2048x1536px; 45° field of view: 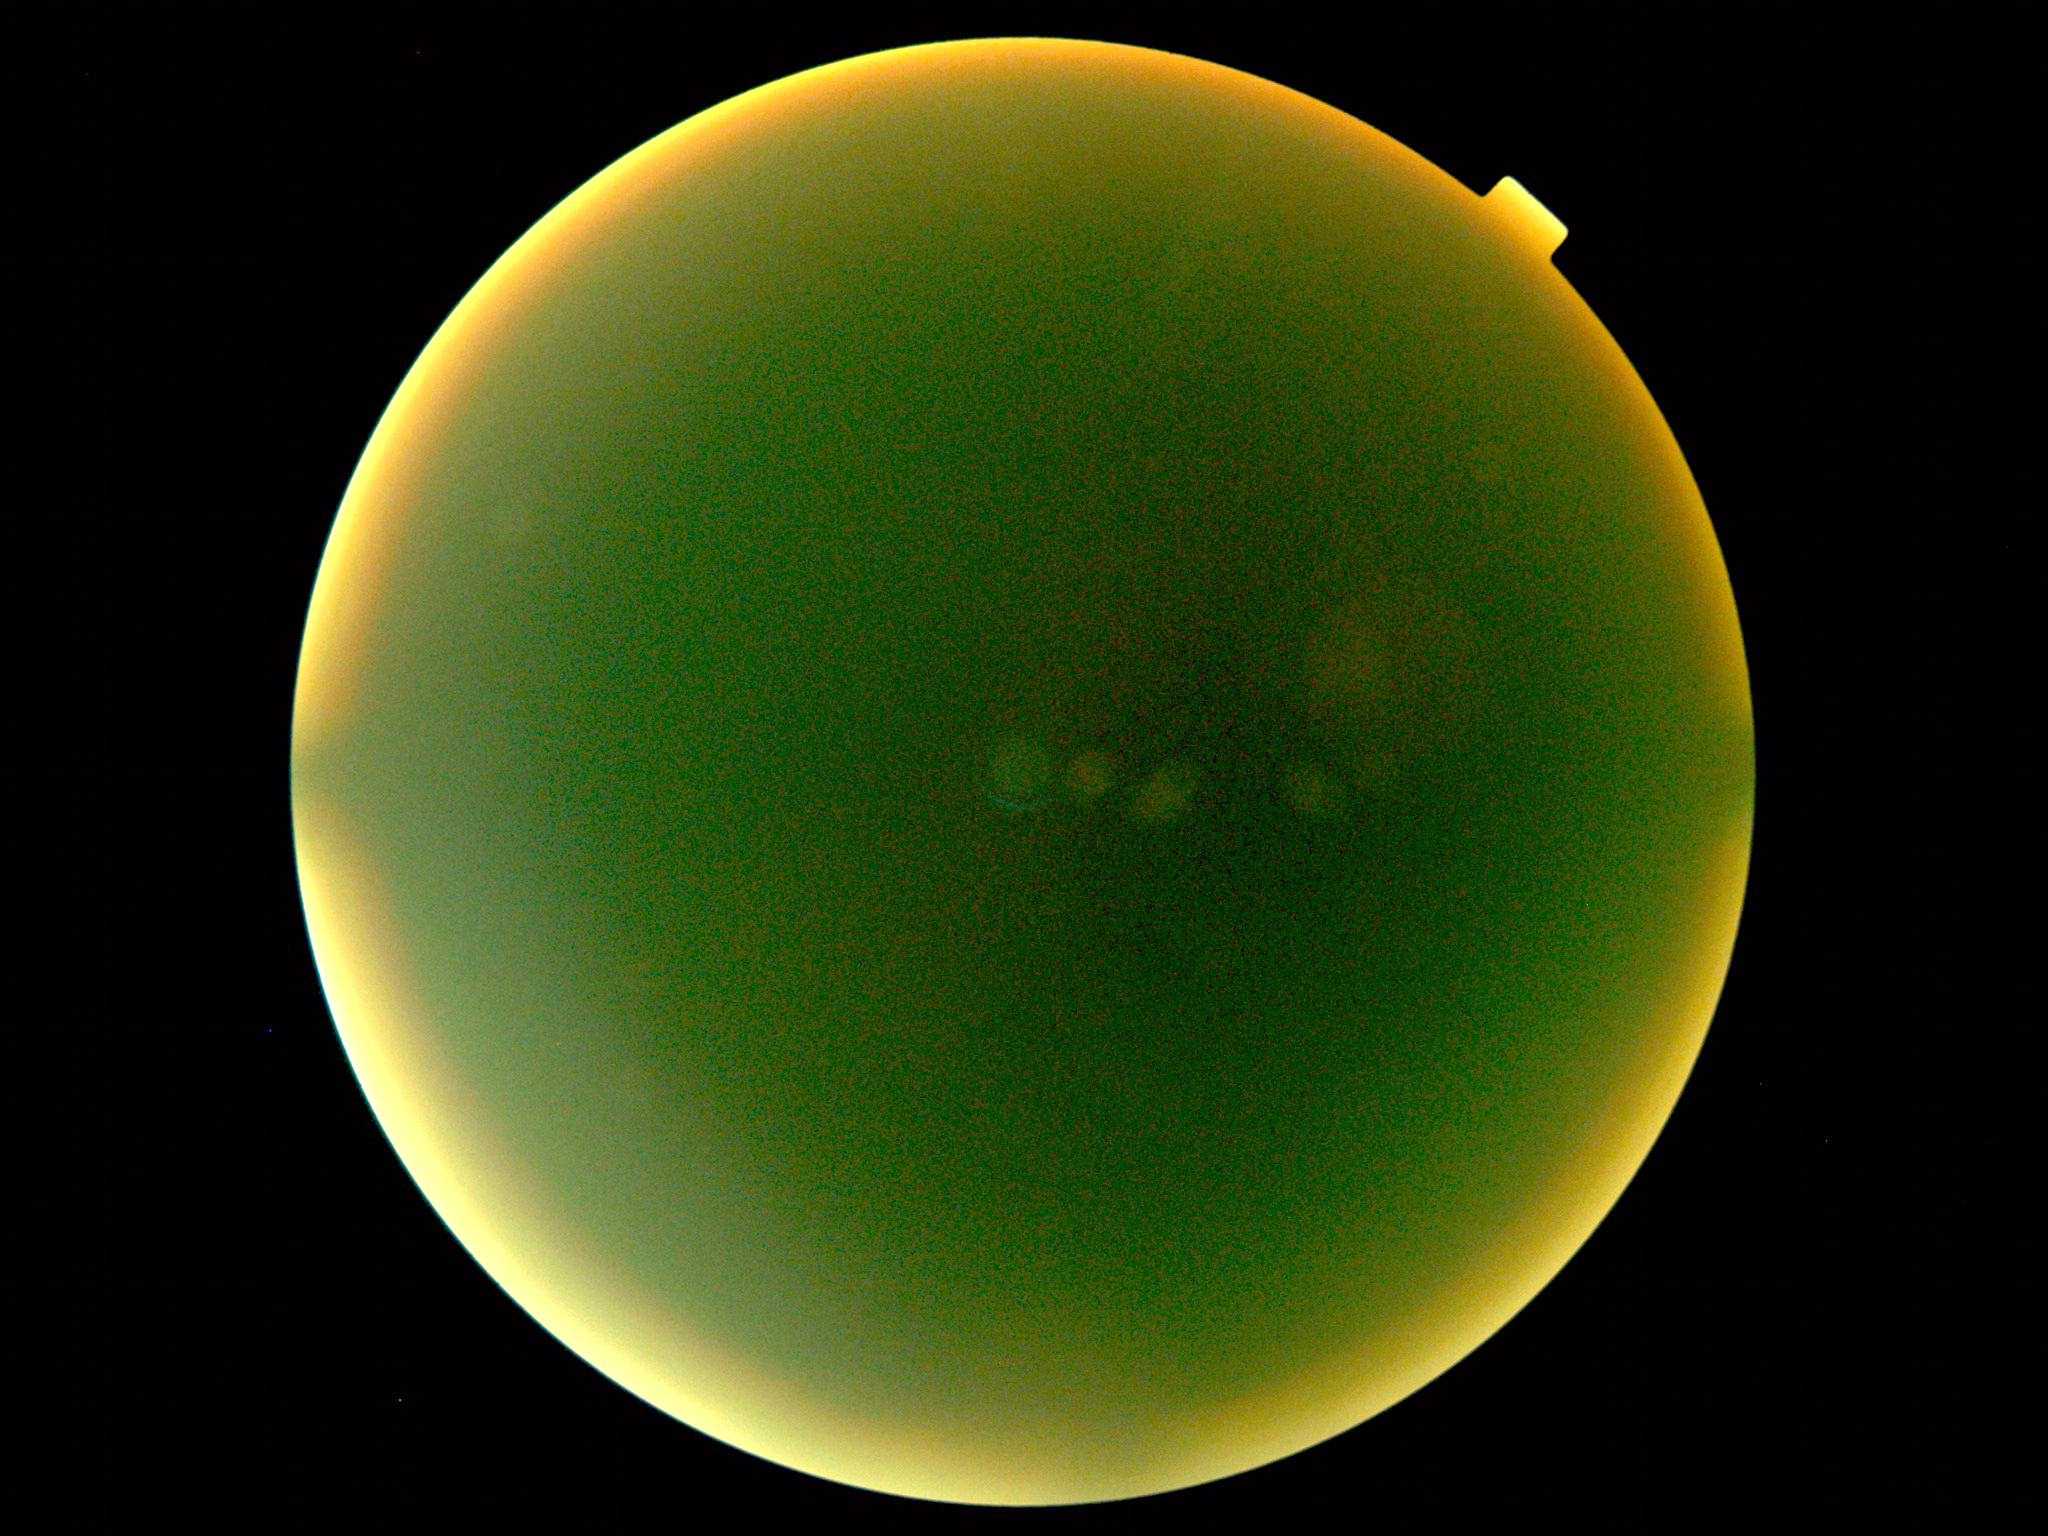

Quality too poor to assess for DR. DR severity: ungradable.